Image size 640x480. Clarity RetCam 3, 130° FOV. Wide-field fundus image from infant ROP screening
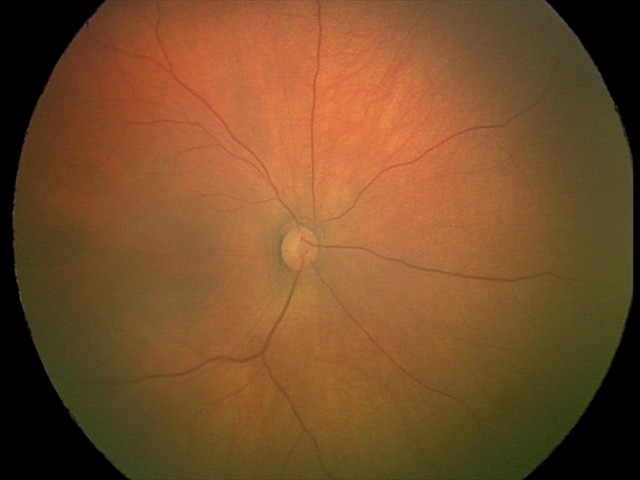 Assessment: no abnormalities.